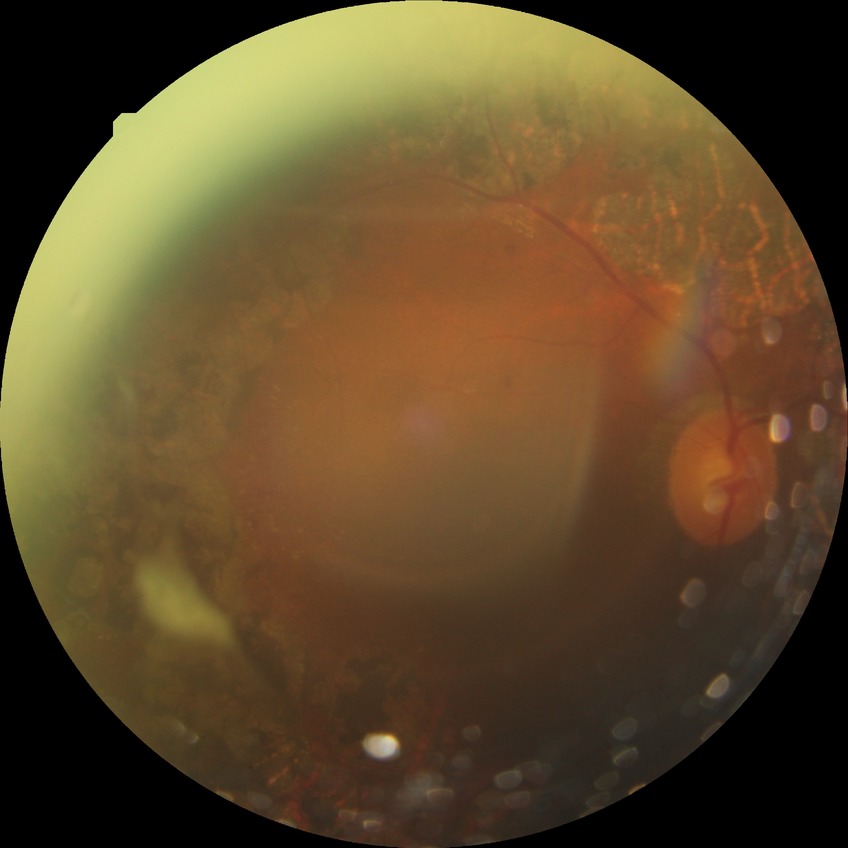   davis_grade: PDR (proliferative diabetic retinopathy)